1932x1932px. 45° FOV. Retinal fundus photograph
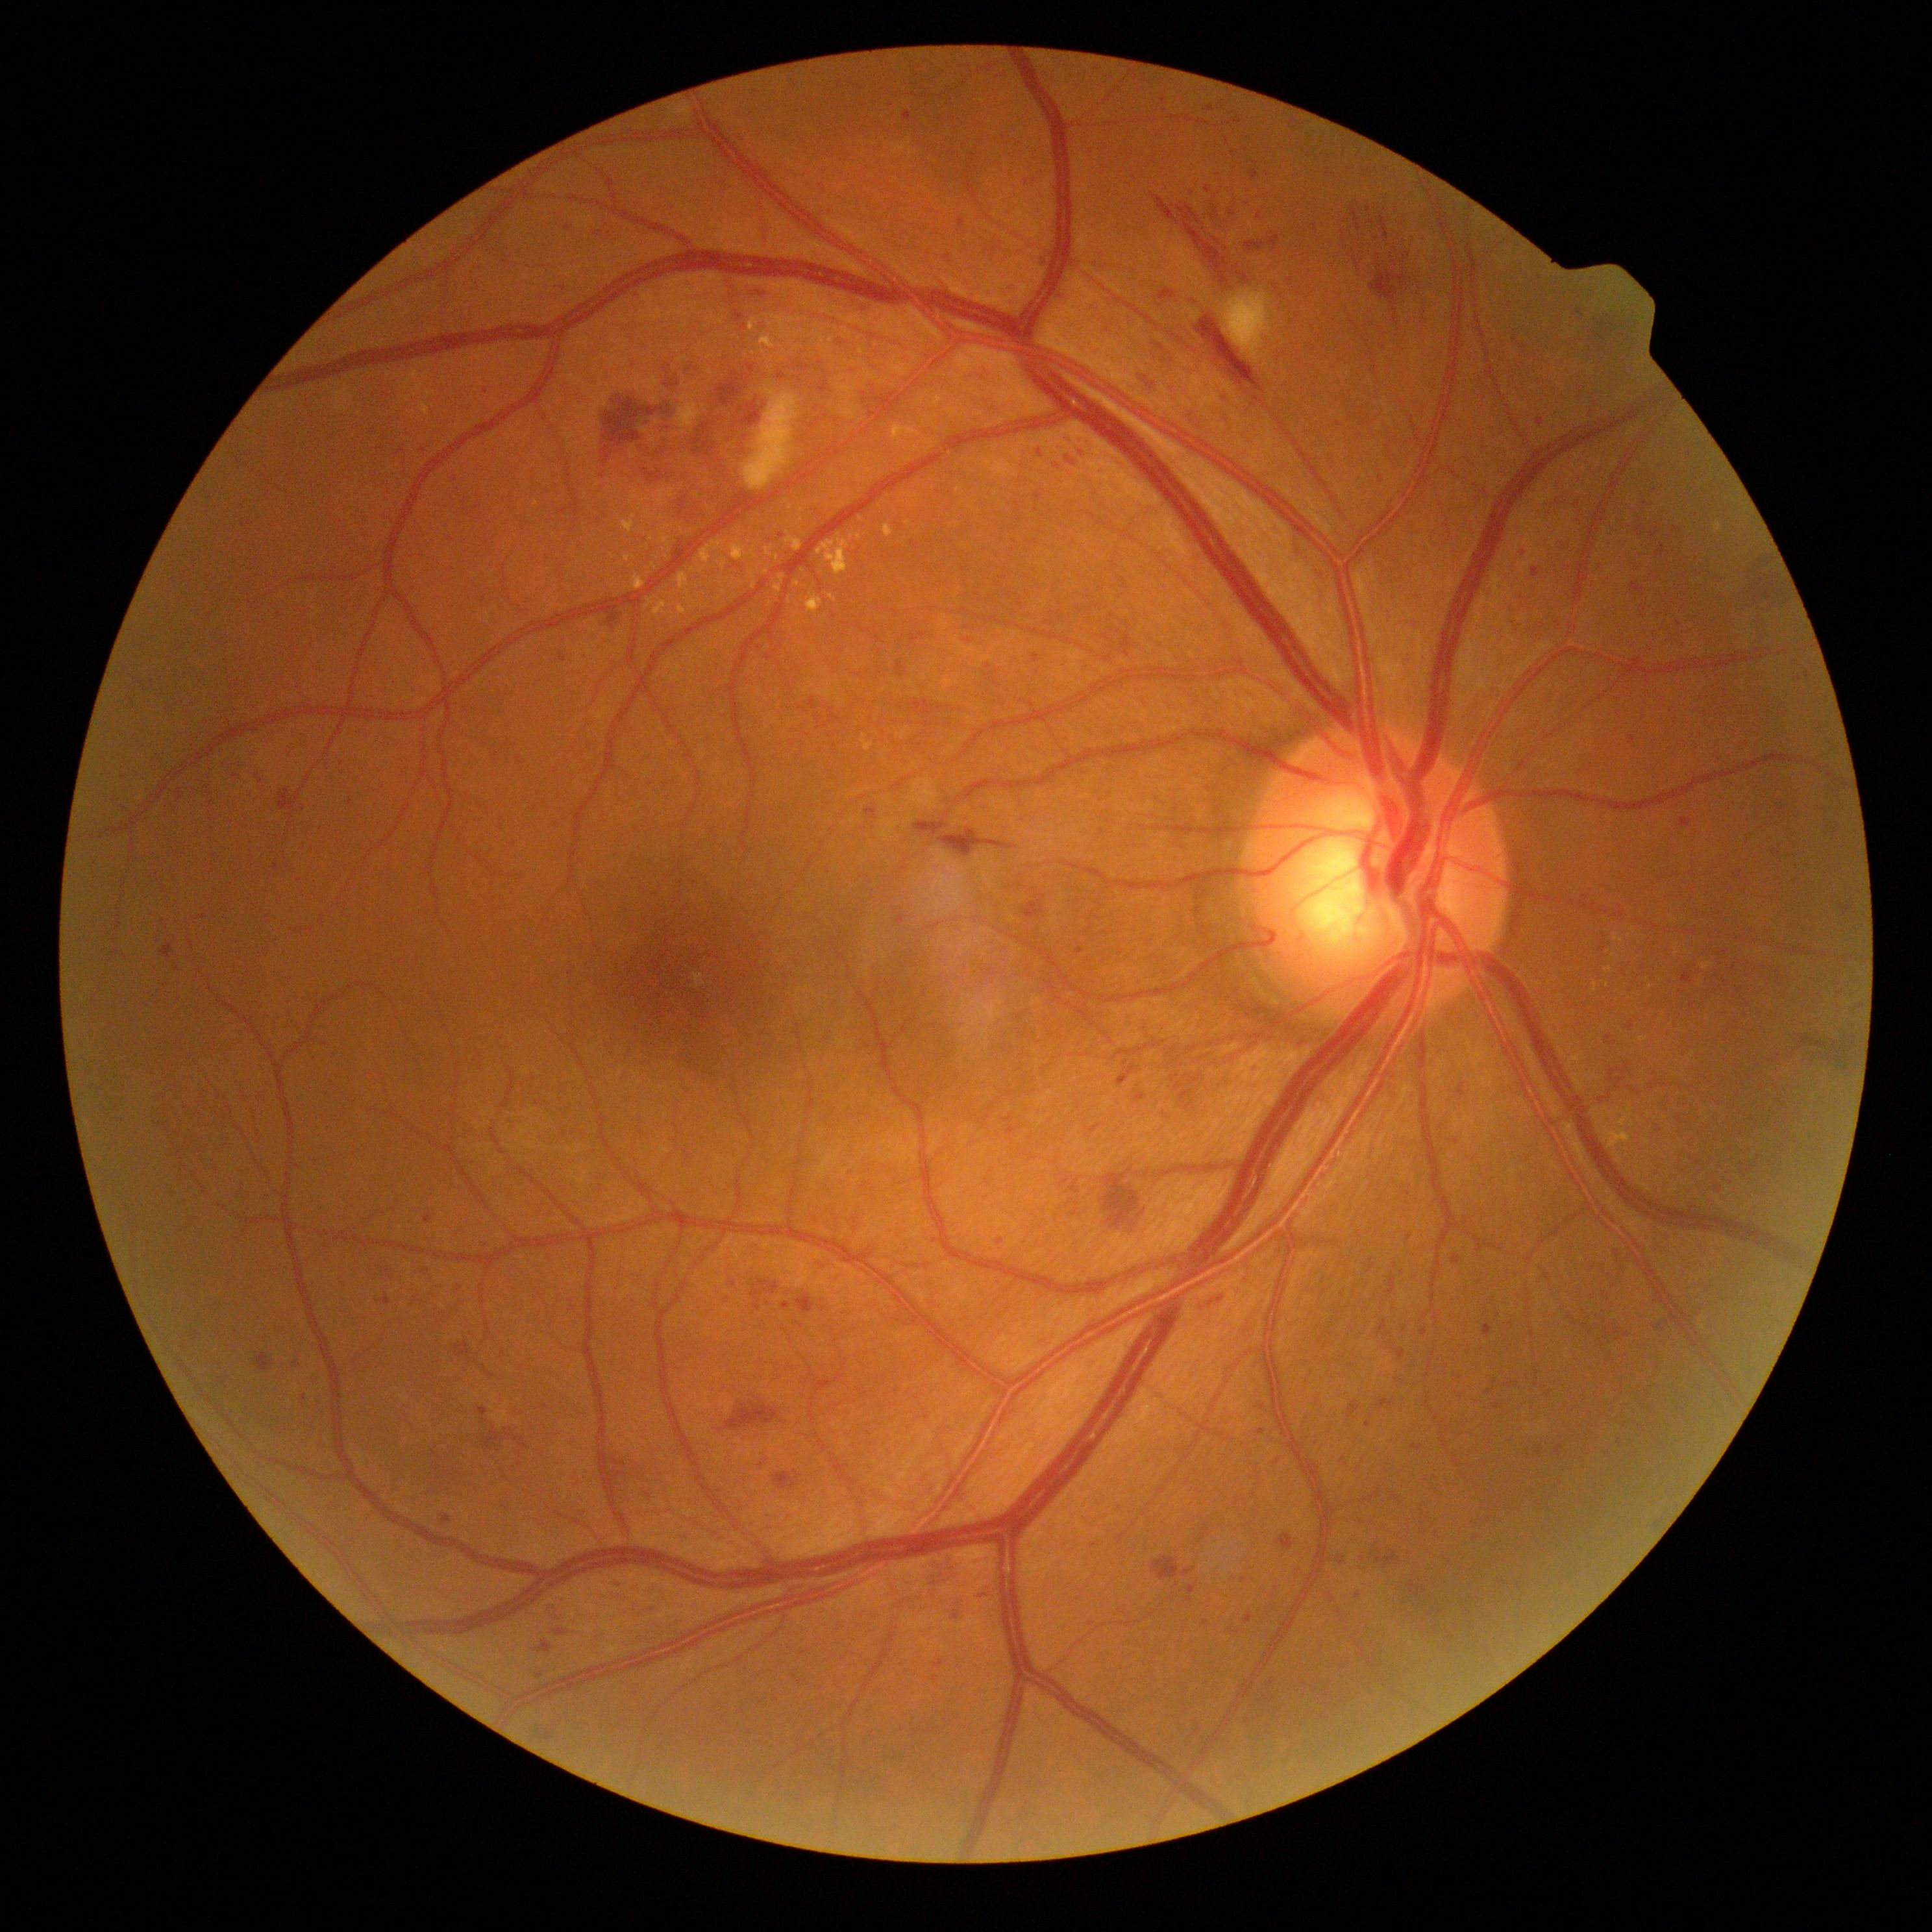

– DR severity: moderate NPDR (grade 2)